Topcon TRC-50DX; color fundus image; image size 2228x1652; central posterior field:
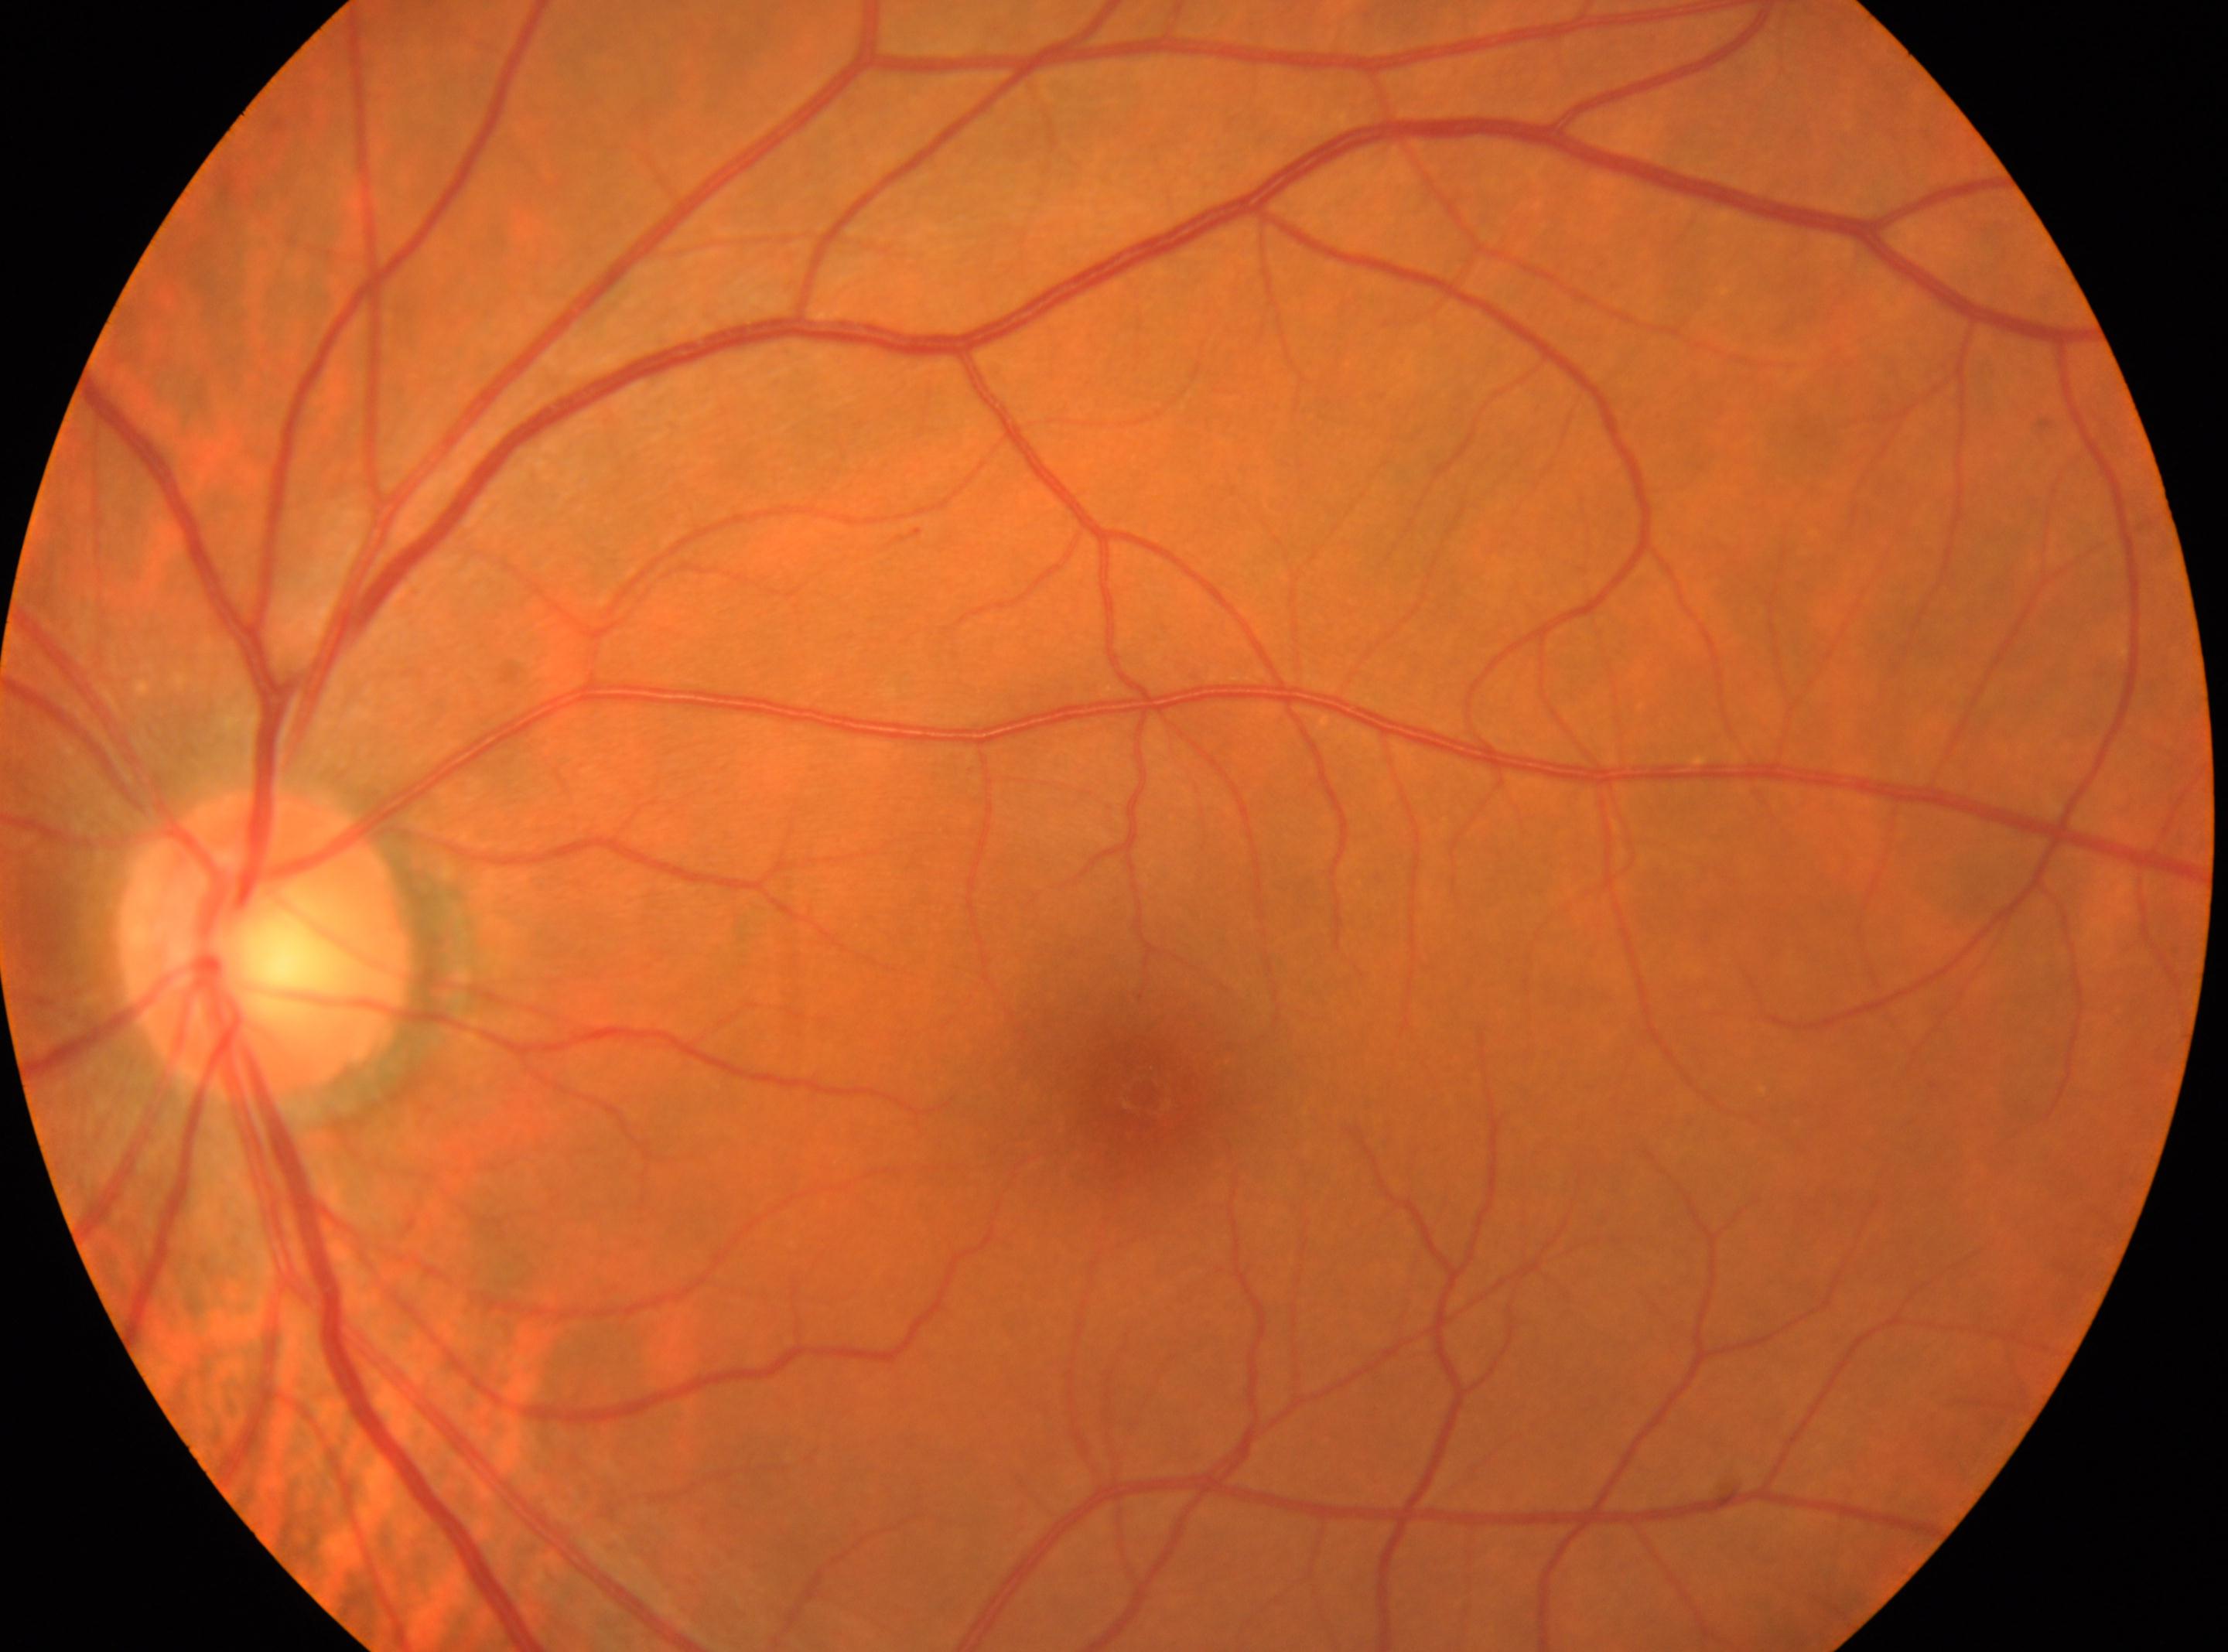
Findings:
* laterality: left
* DR impression: No DR findings
* DR: grade 0 (no apparent retinopathy) — no visible signs of diabetic retinopathy
* fovea: (1145,1094)
* ONH: (266,944)